45° field of view, CFP, 848 by 848 pixels, acquired with a NIDEK AFC-230, modified Davis classification:
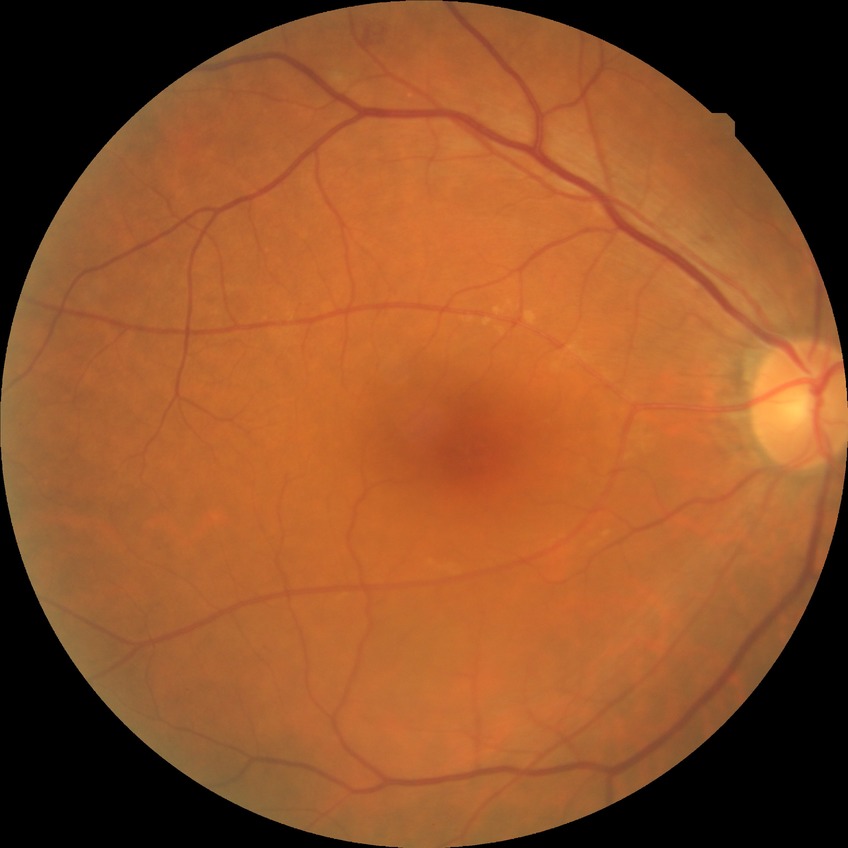

Diabetic retinopathy severity is simple diabetic retinopathy.